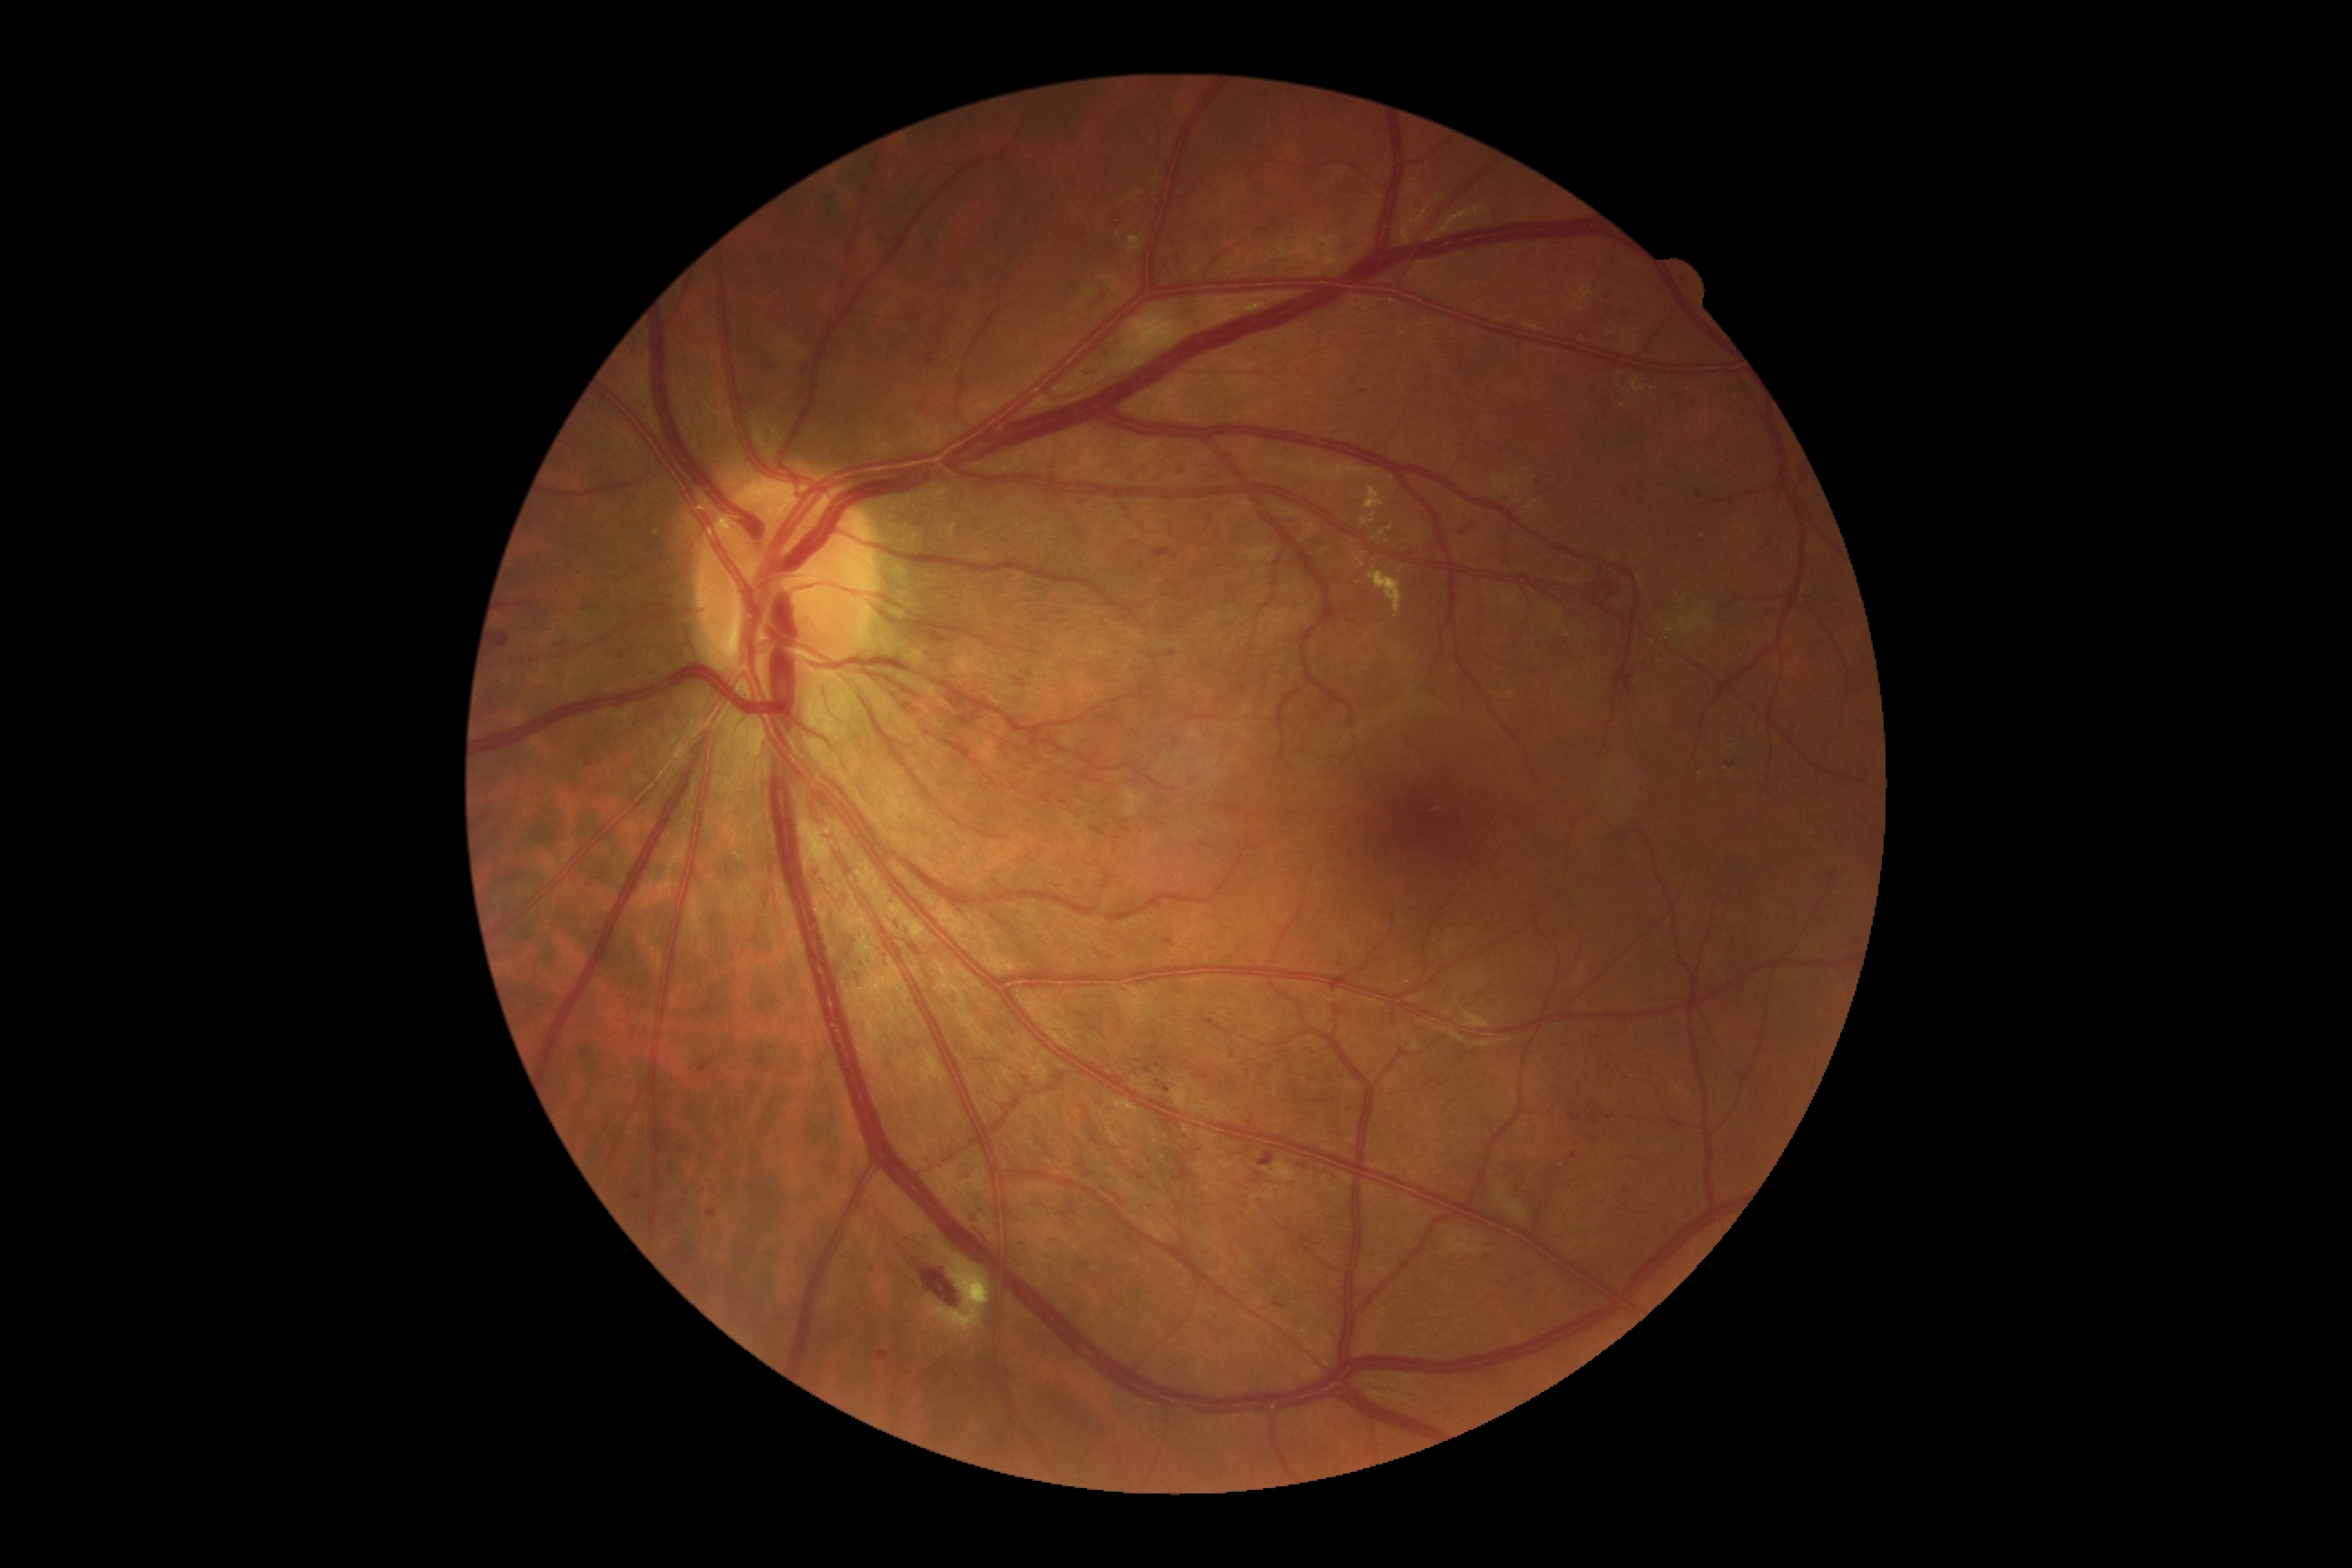

Diabetic retinopathy (DR): grade 2
Representative lesions:
* hemorrhages (HEs) (partial): x1=925, y1=357, x2=934, y2=368; x1=1656, y1=651, x2=1667, y2=662; x1=1725, y1=761, x2=1736, y2=770; x1=1569, y1=1113, x2=1582, y2=1122; x1=879, y1=1351, x2=890, y2=1362; x1=1208, y1=471, x2=1226, y2=485; x1=1335, y1=1072, x2=1344, y2=1081; x1=1331, y1=959, x2=1344, y2=970; x1=1638, y1=785, x2=1647, y2=792; x1=1173, y1=1166, x2=1195, y2=1182; x1=850, y1=968, x2=861, y2=988; x1=1594, y1=565, x2=1605, y2=573; x1=1112, y1=217, x2=1124, y2=230; x1=1623, y1=662, x2=1649, y2=698
* Smaller HEs around 1232, 1057; 1364, 393; 1181, 472; 1677, 547; 600, 761; 1175, 557